640x480px; RetCam wide-field infant fundus image:
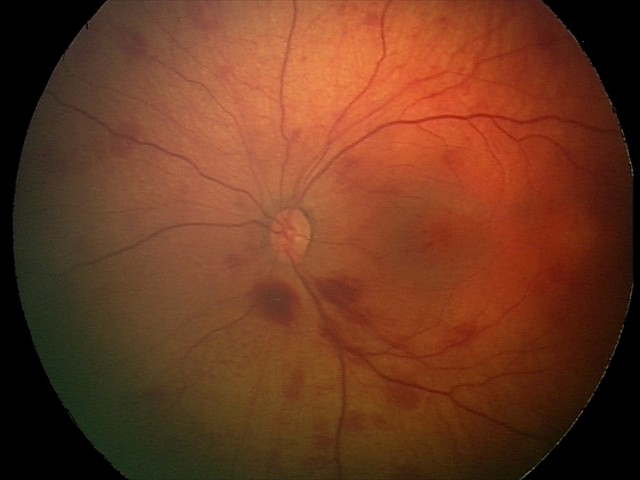

Series diagnosed as retinal hemorrhages.